45° FOV, CFP:
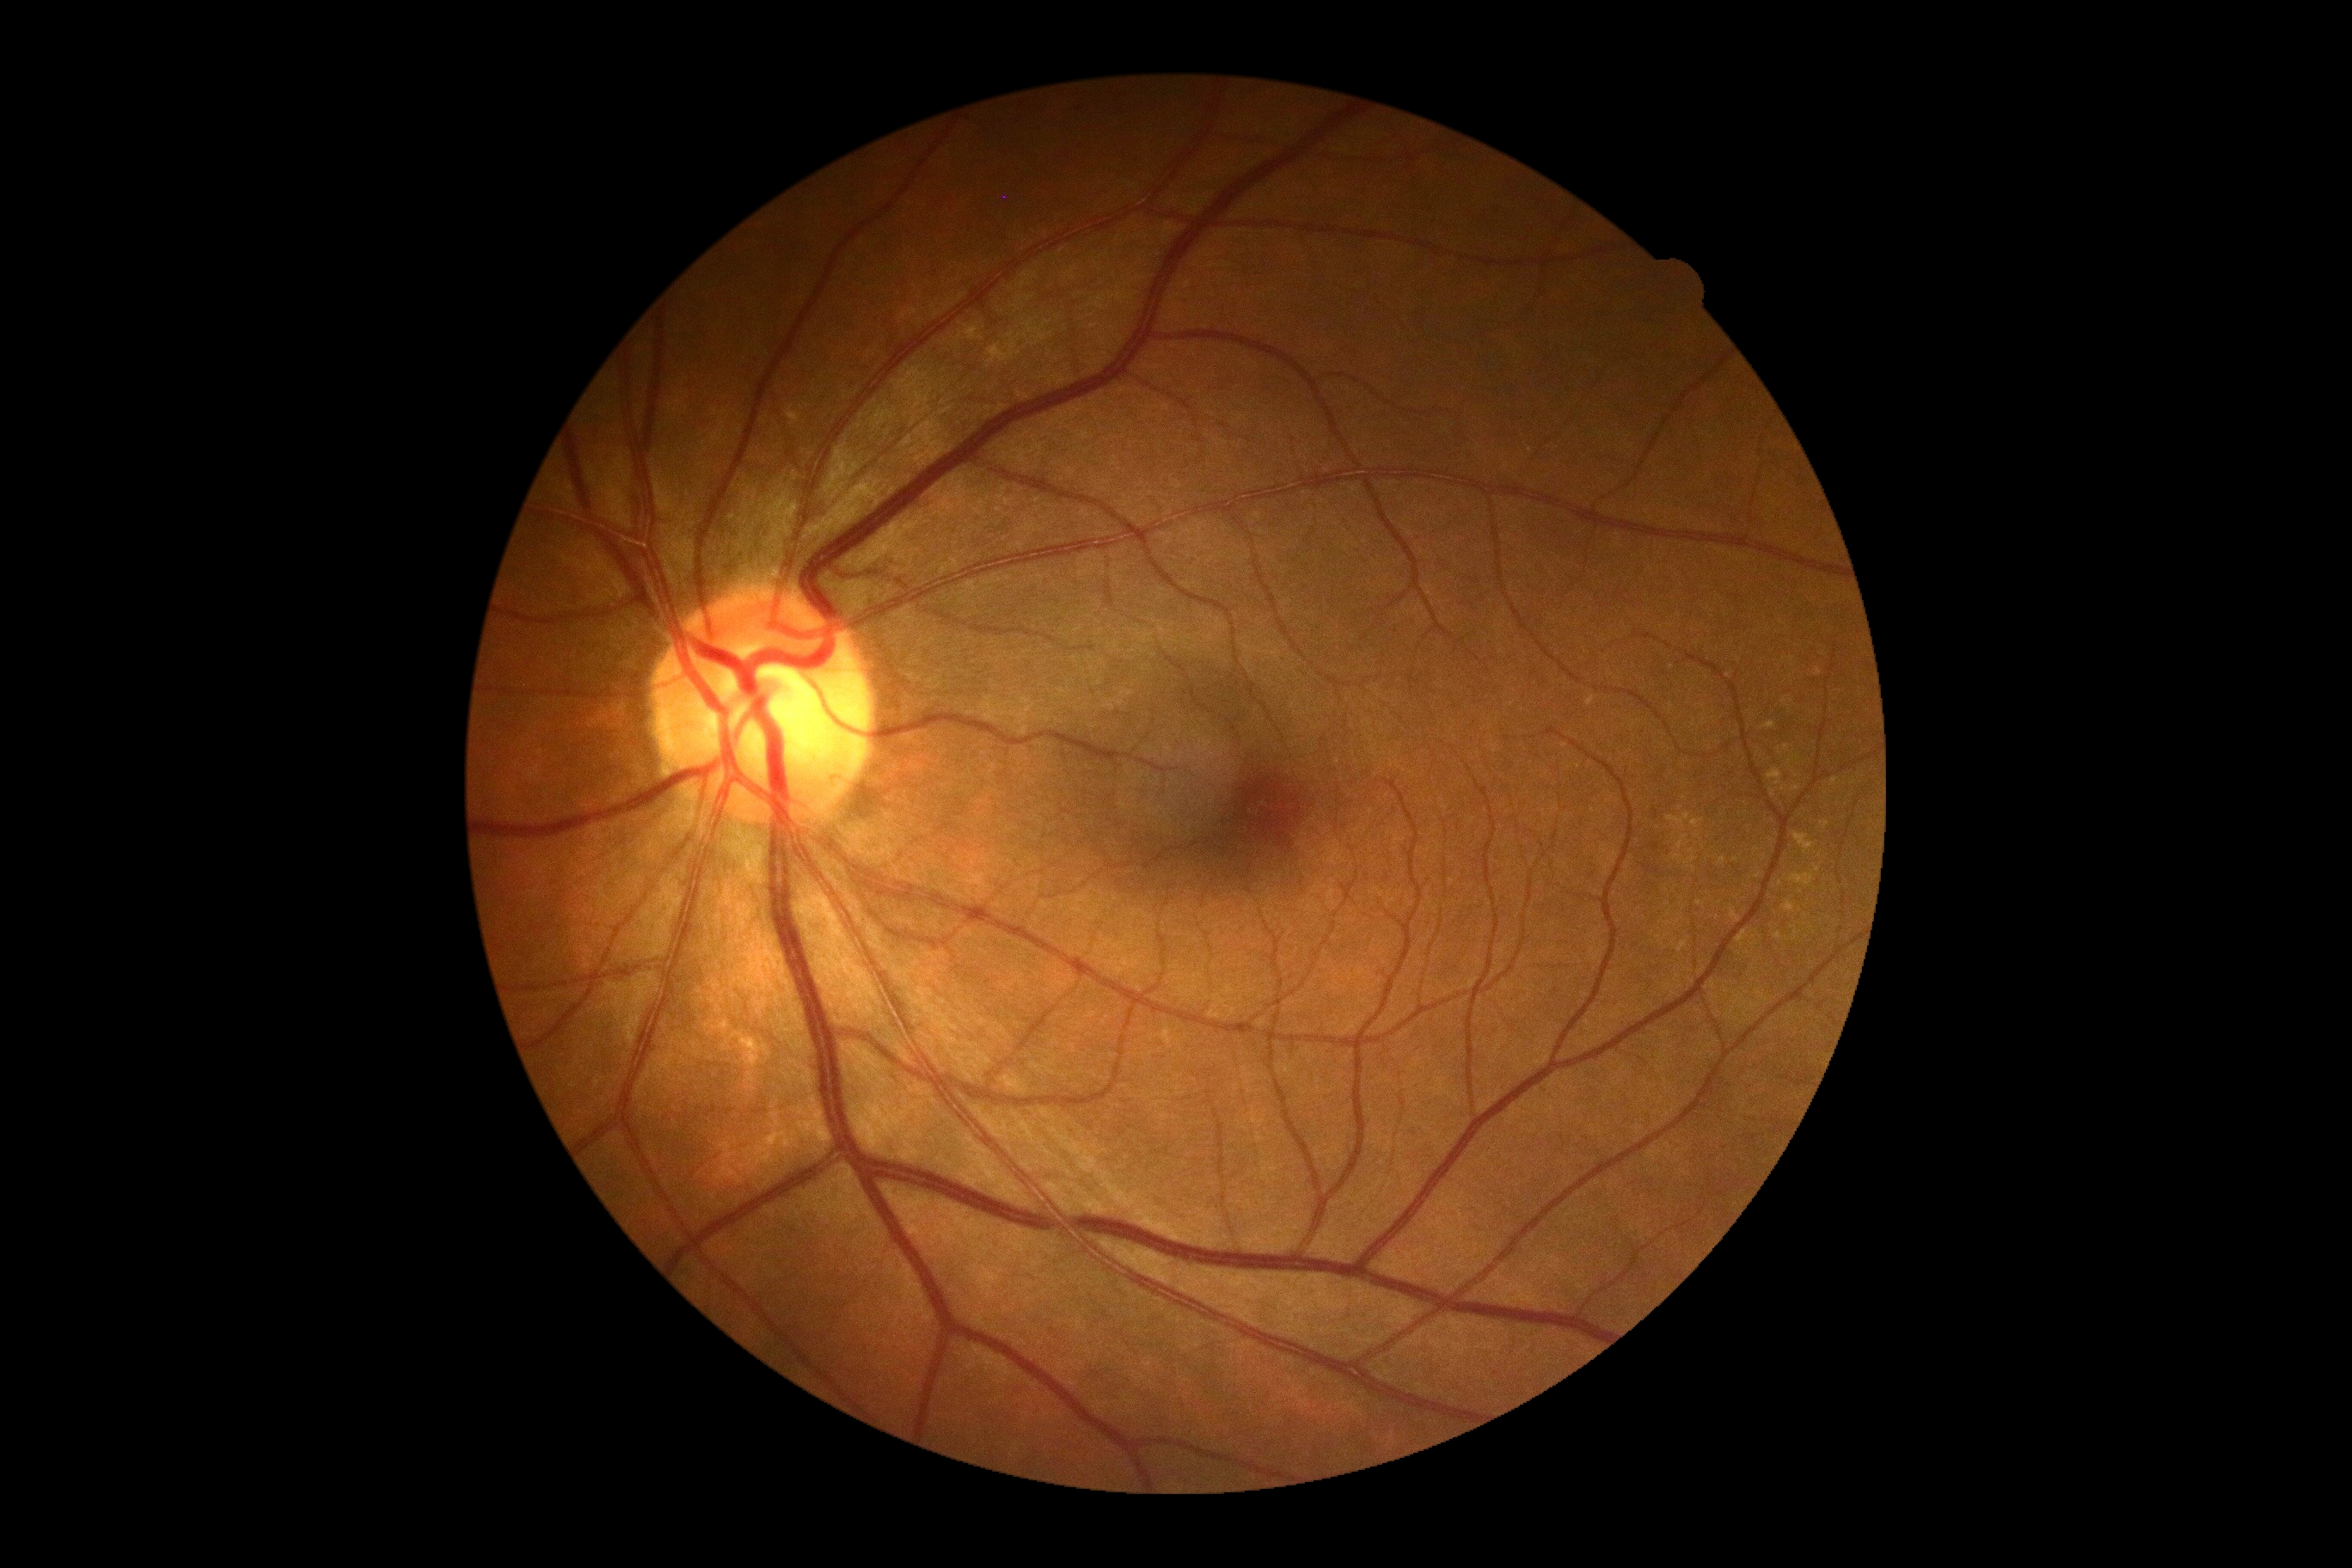

DR severity = no apparent retinopathy (grade 0); DR impression = no signs of DR.